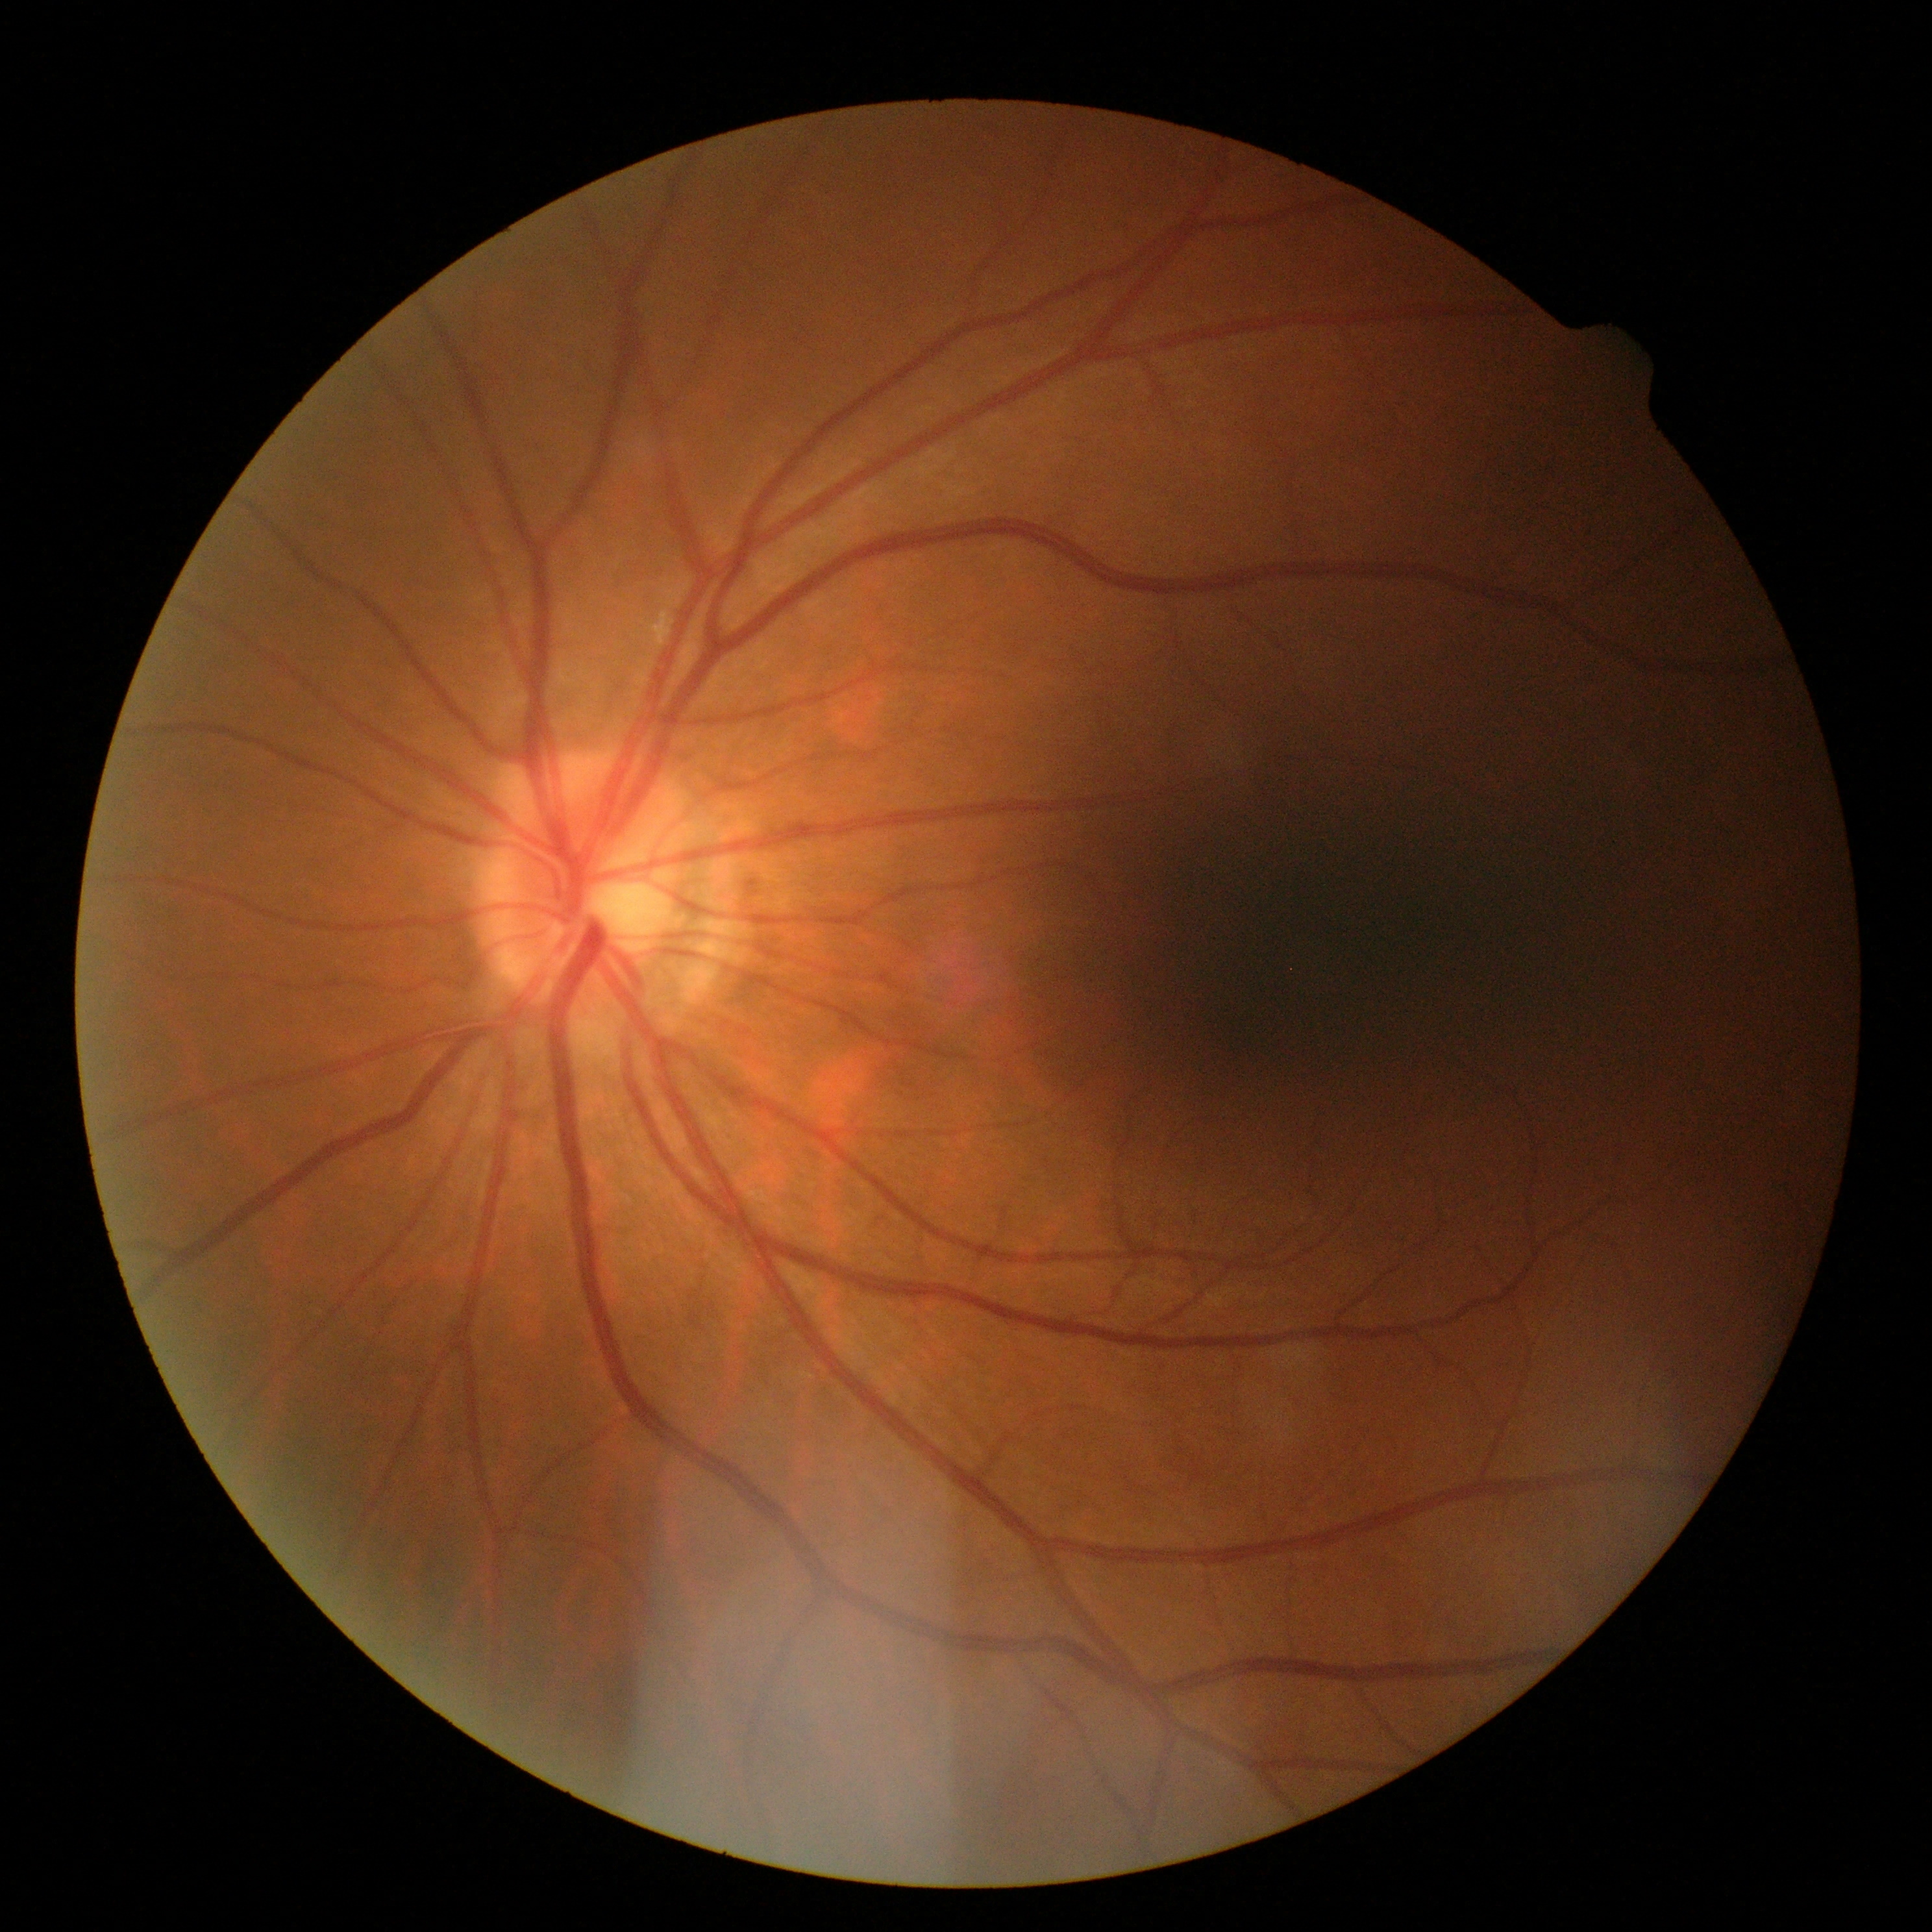   dr_grade: grade 0 (no apparent retinopathy) — no visible signs of diabetic retinopathy
  dr_impression: no apparent DR